Wide-field contact fundus photograph of an infant. Captured with the Phoenix ICON (100° field of view). 1240 x 1240 pixels: 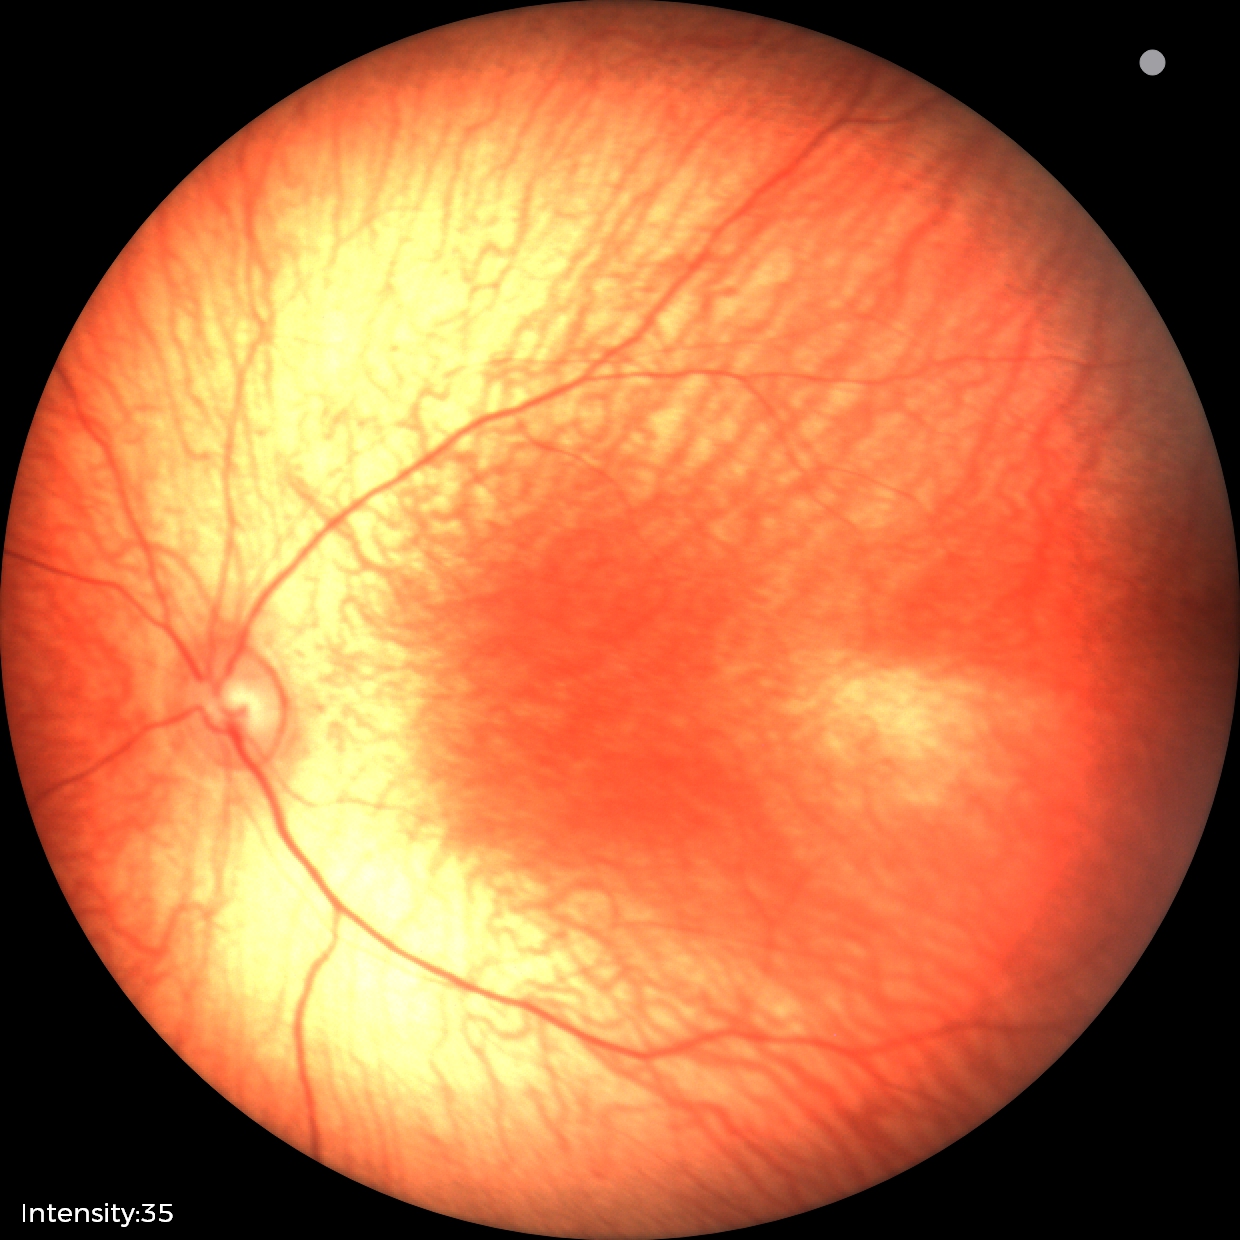 Physiological retinal appearance for postconceptual age.